Acquired on the Phoenix ICON; pediatric retinal photograph (wide-field); image size 1240x1240: 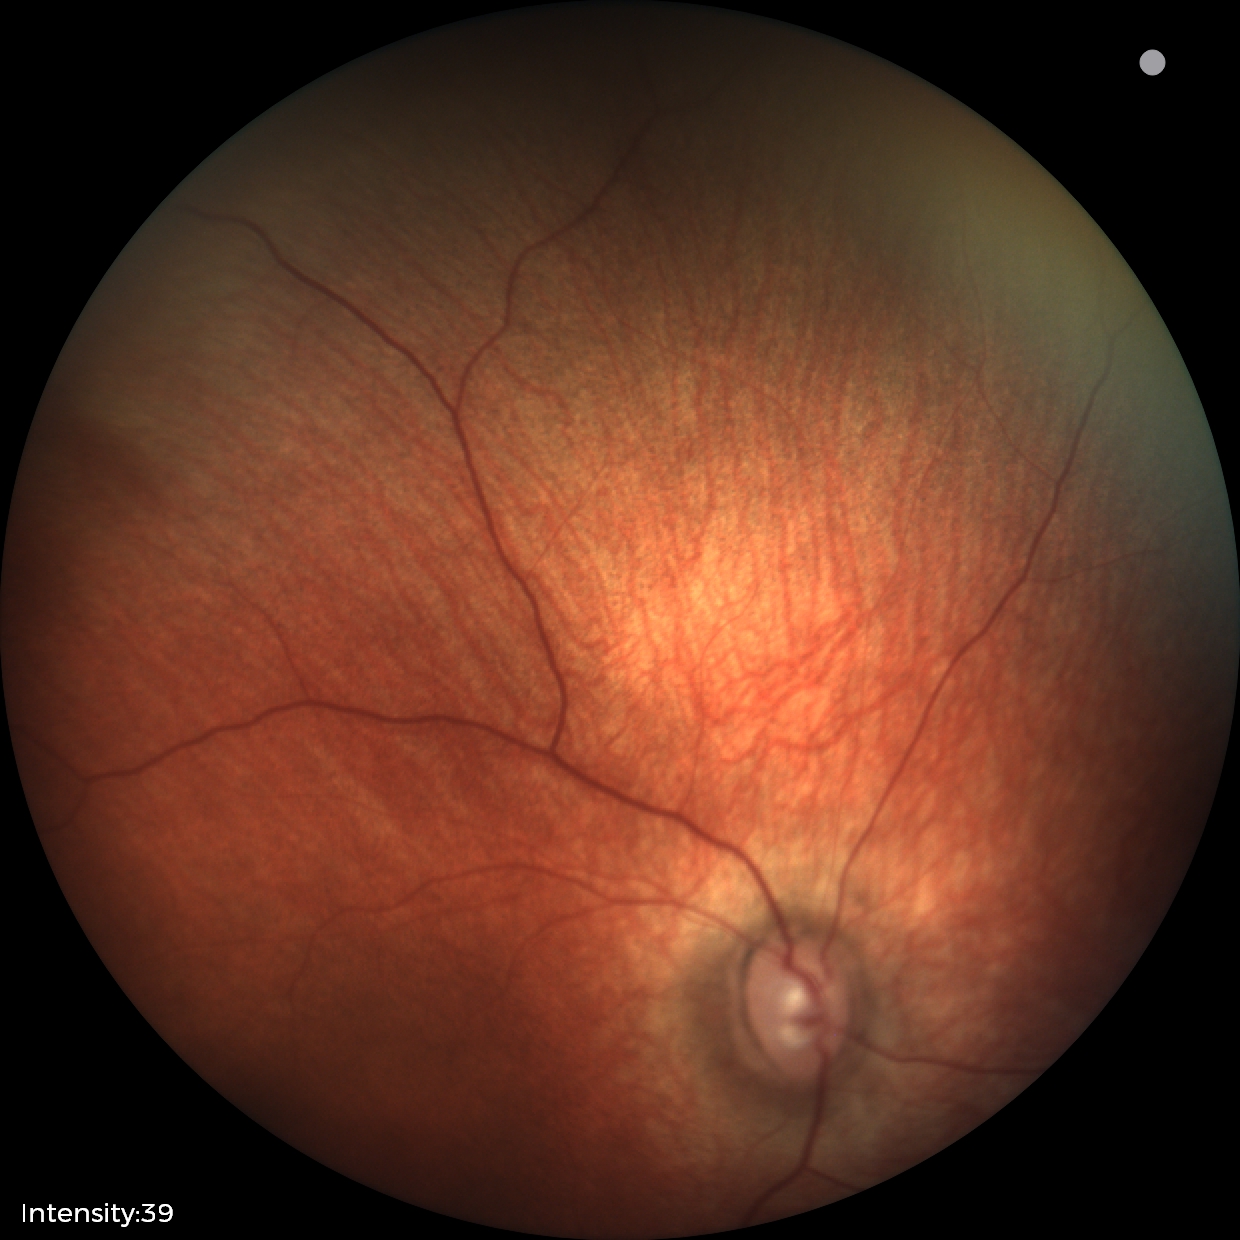
Q: What is the diagnosis from this examination?
A: physiological finding